2352x1568px — 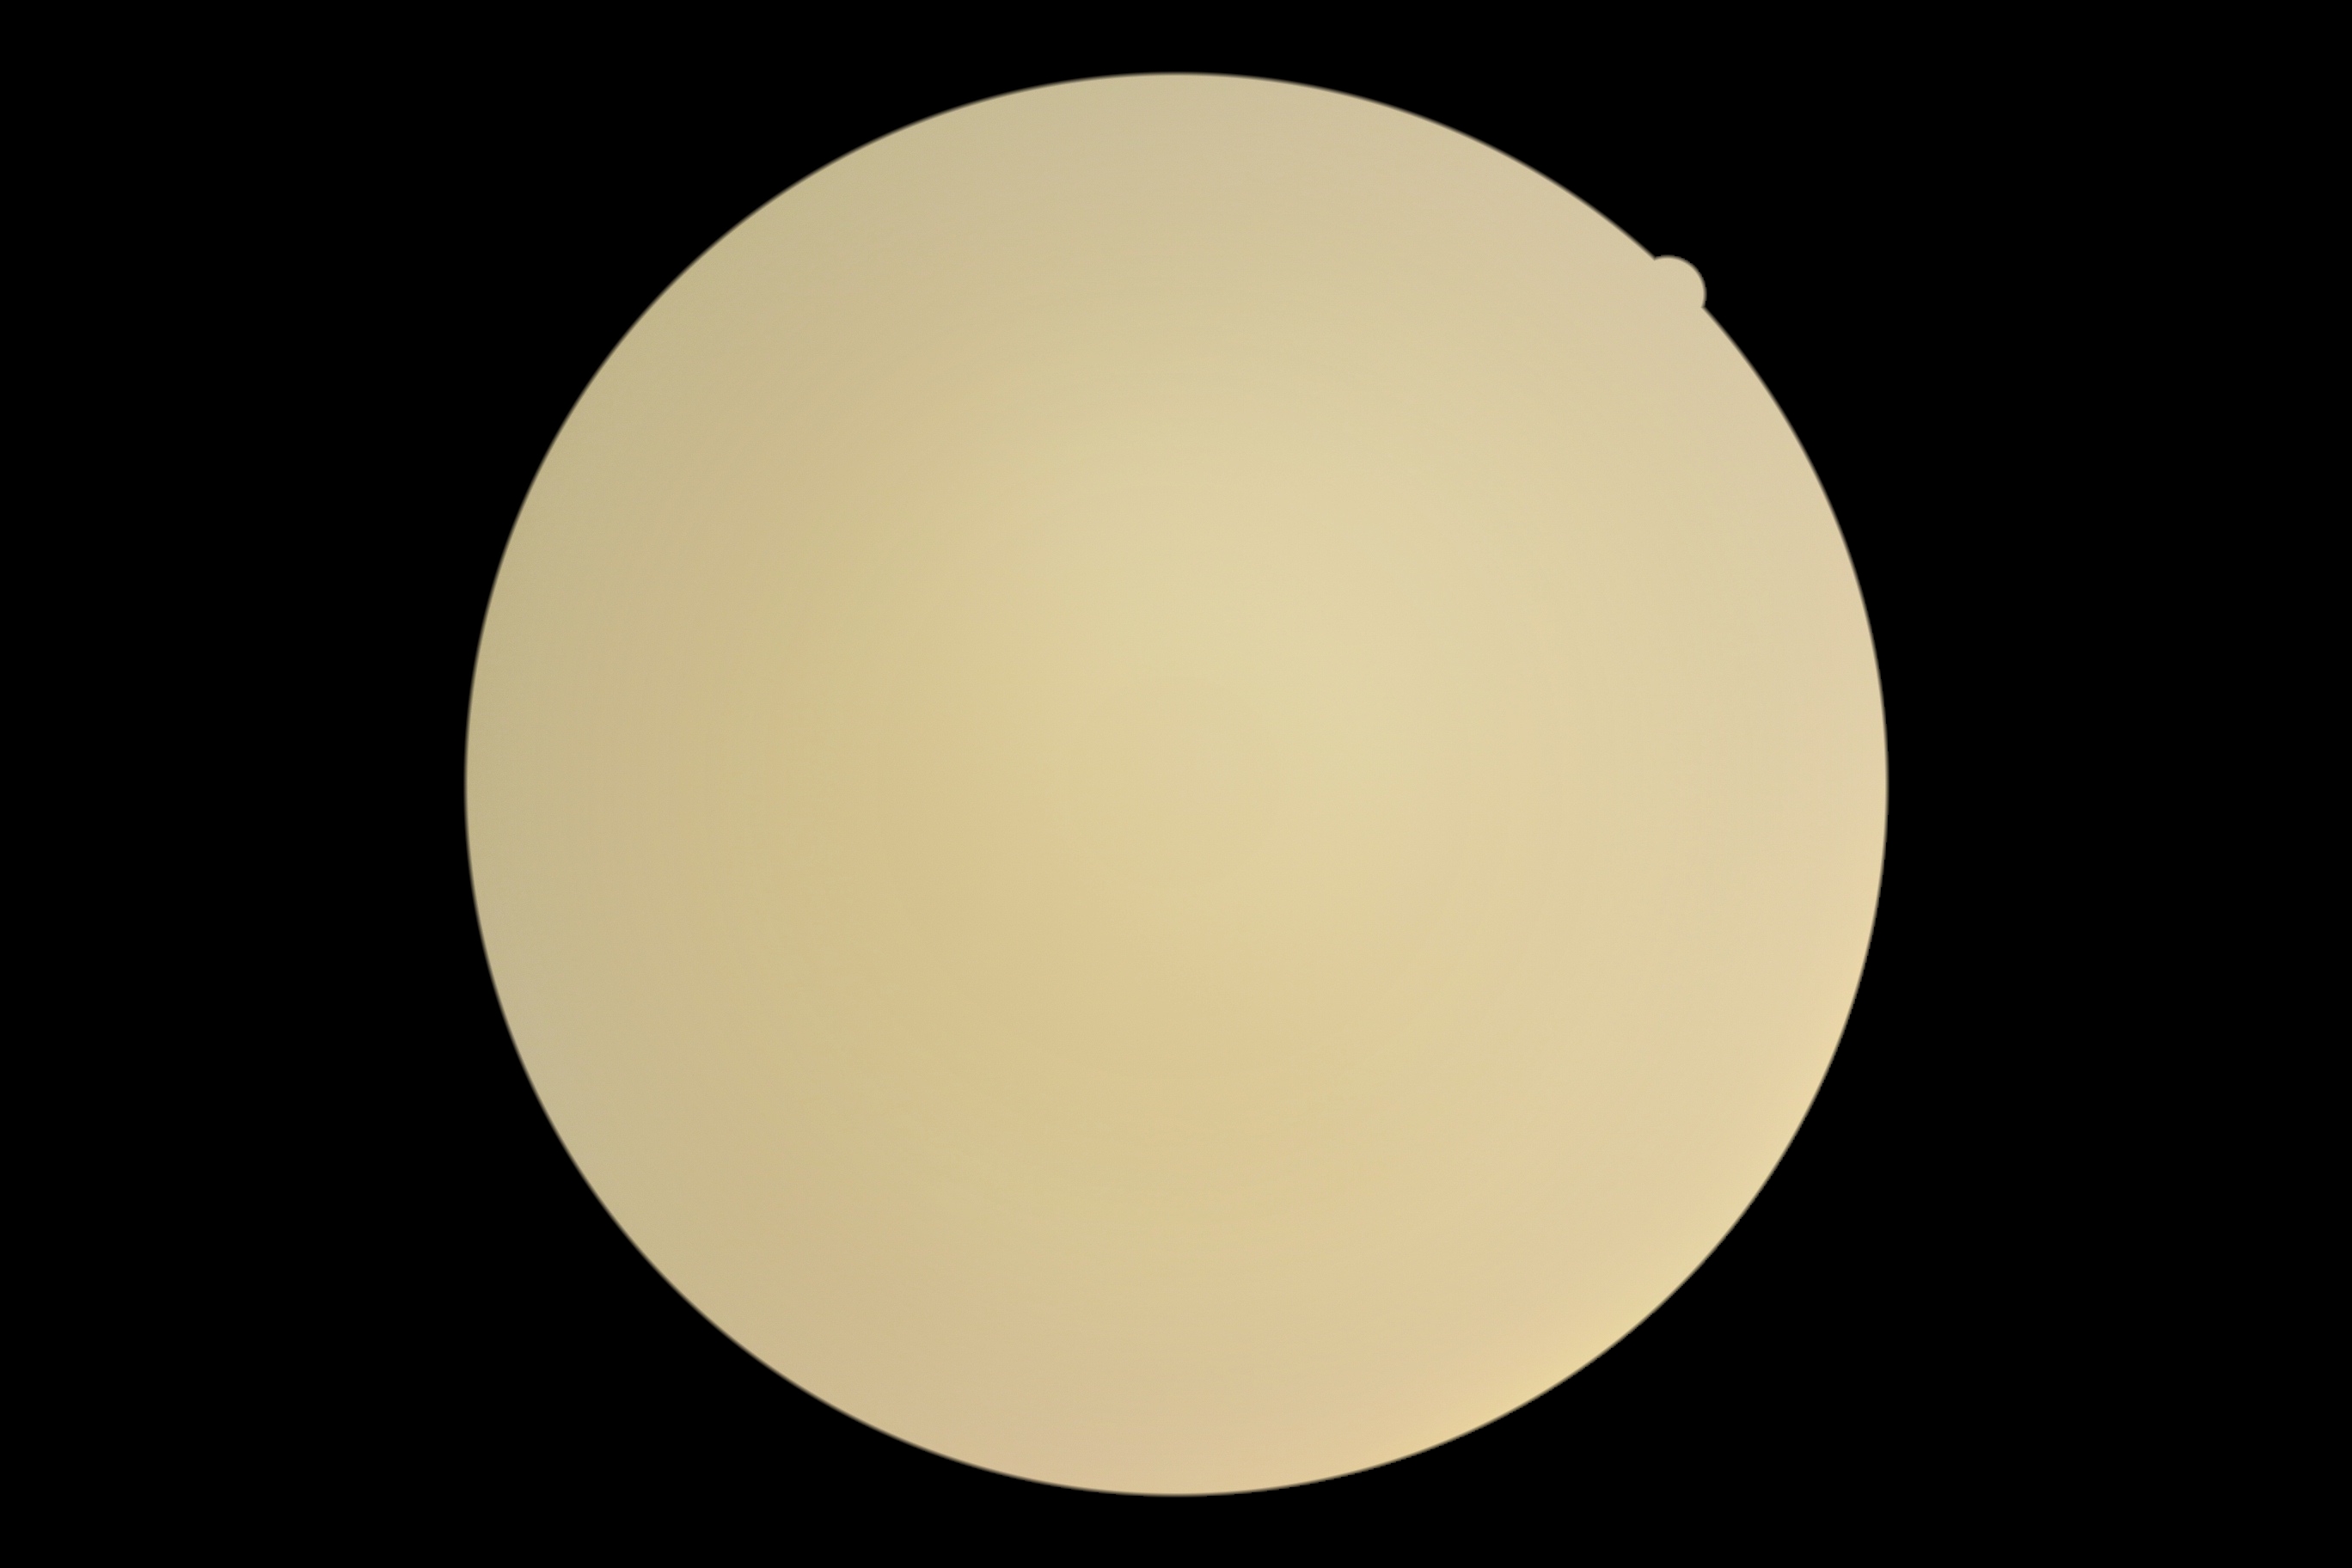 Retinopathy is ungradable.